100° field of view (Phoenix ICON); wide-field fundus image from infant ROP screening: 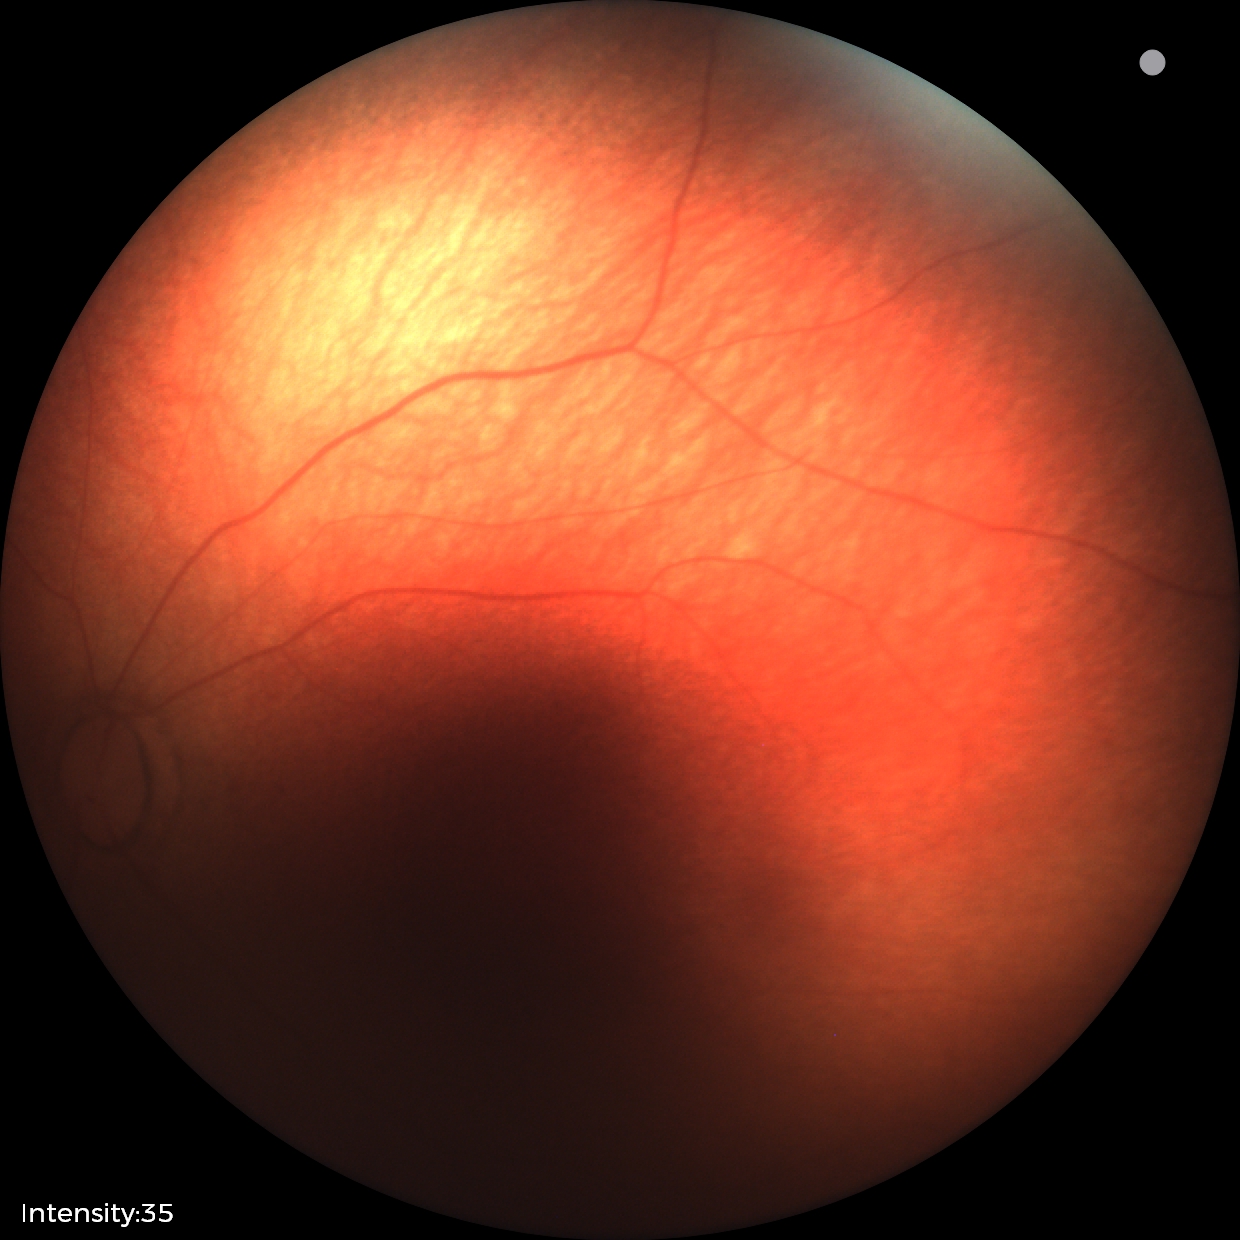 Normal screening examination.